Fundus photo taken with a portable handheld camera
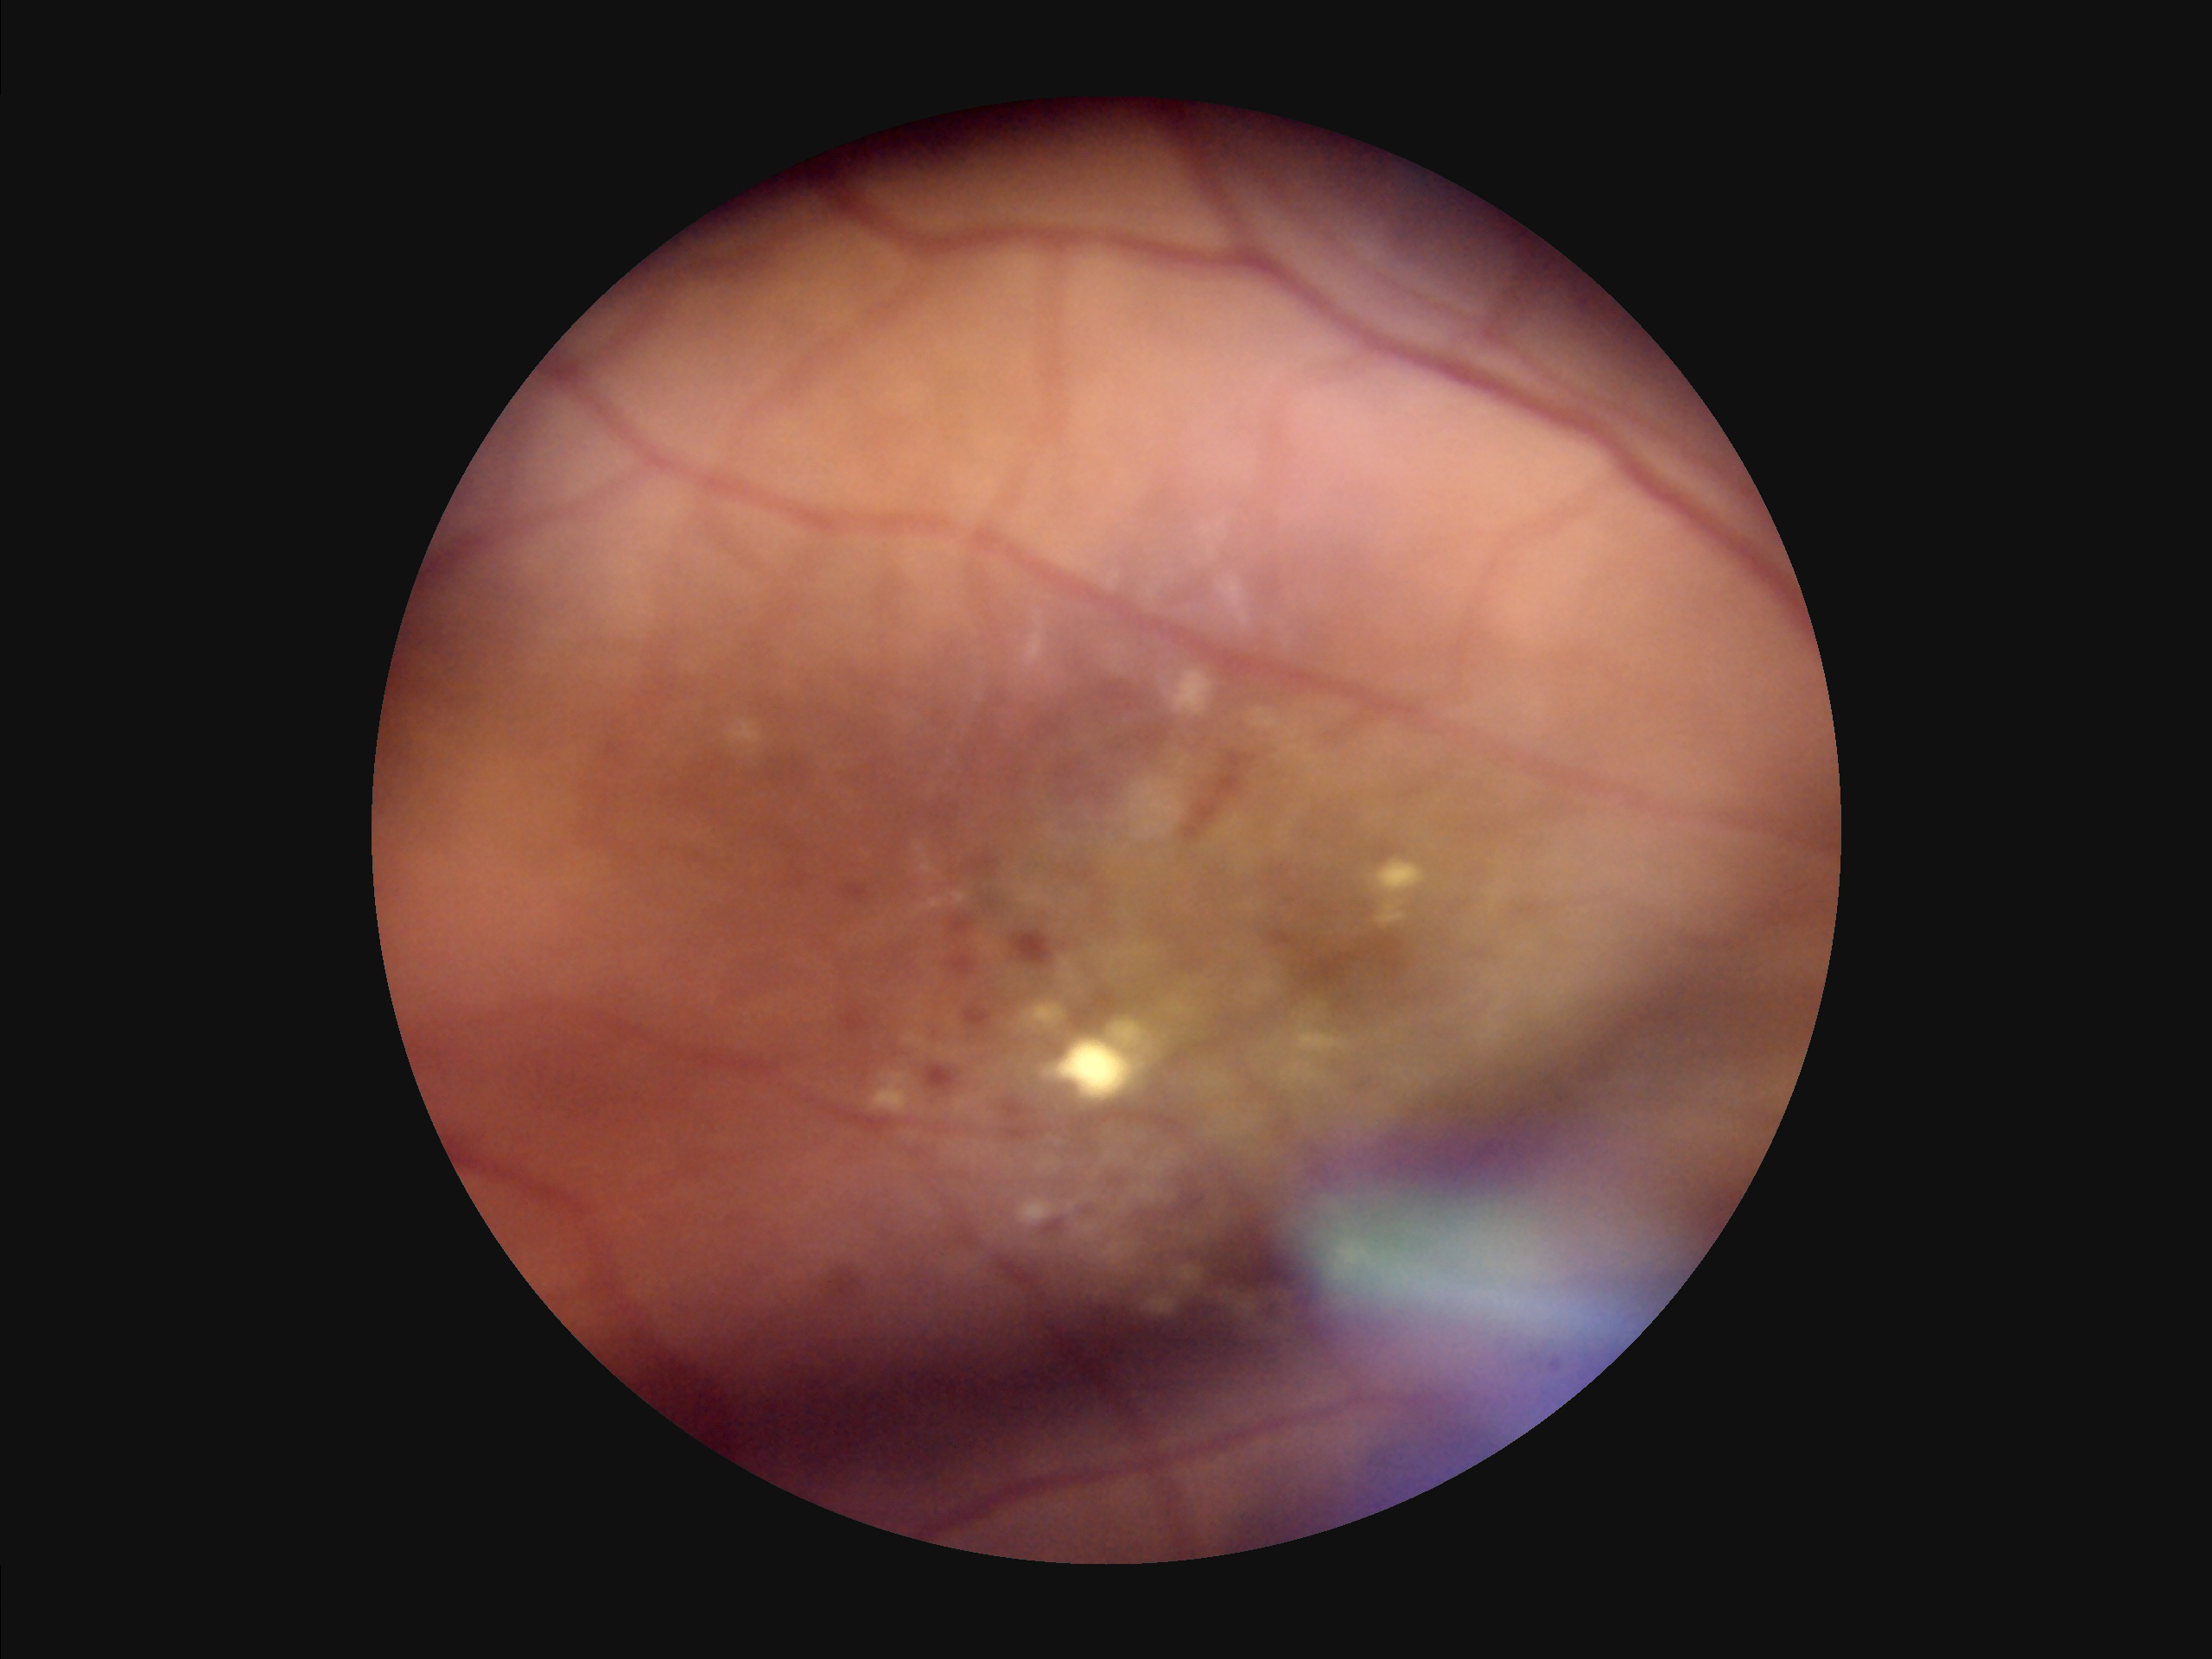
Illumination is uneven. Overall quality is poor; the image is difficult to grade. Reduced sharpness with visible blur.